Image size 512x512, fundus photo
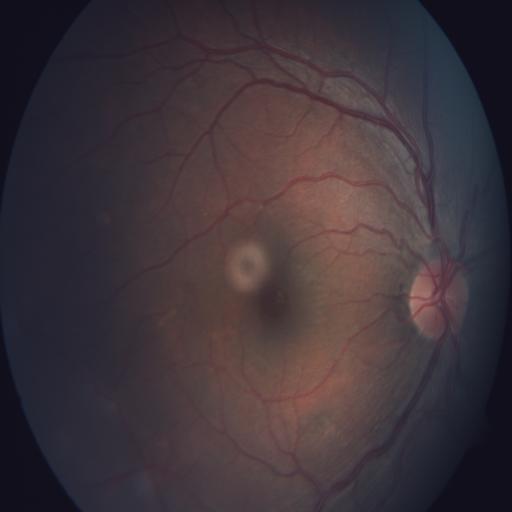 Diagnosis (2):
- media haze
- macular hole